Color fundus image; 2089x1764px — 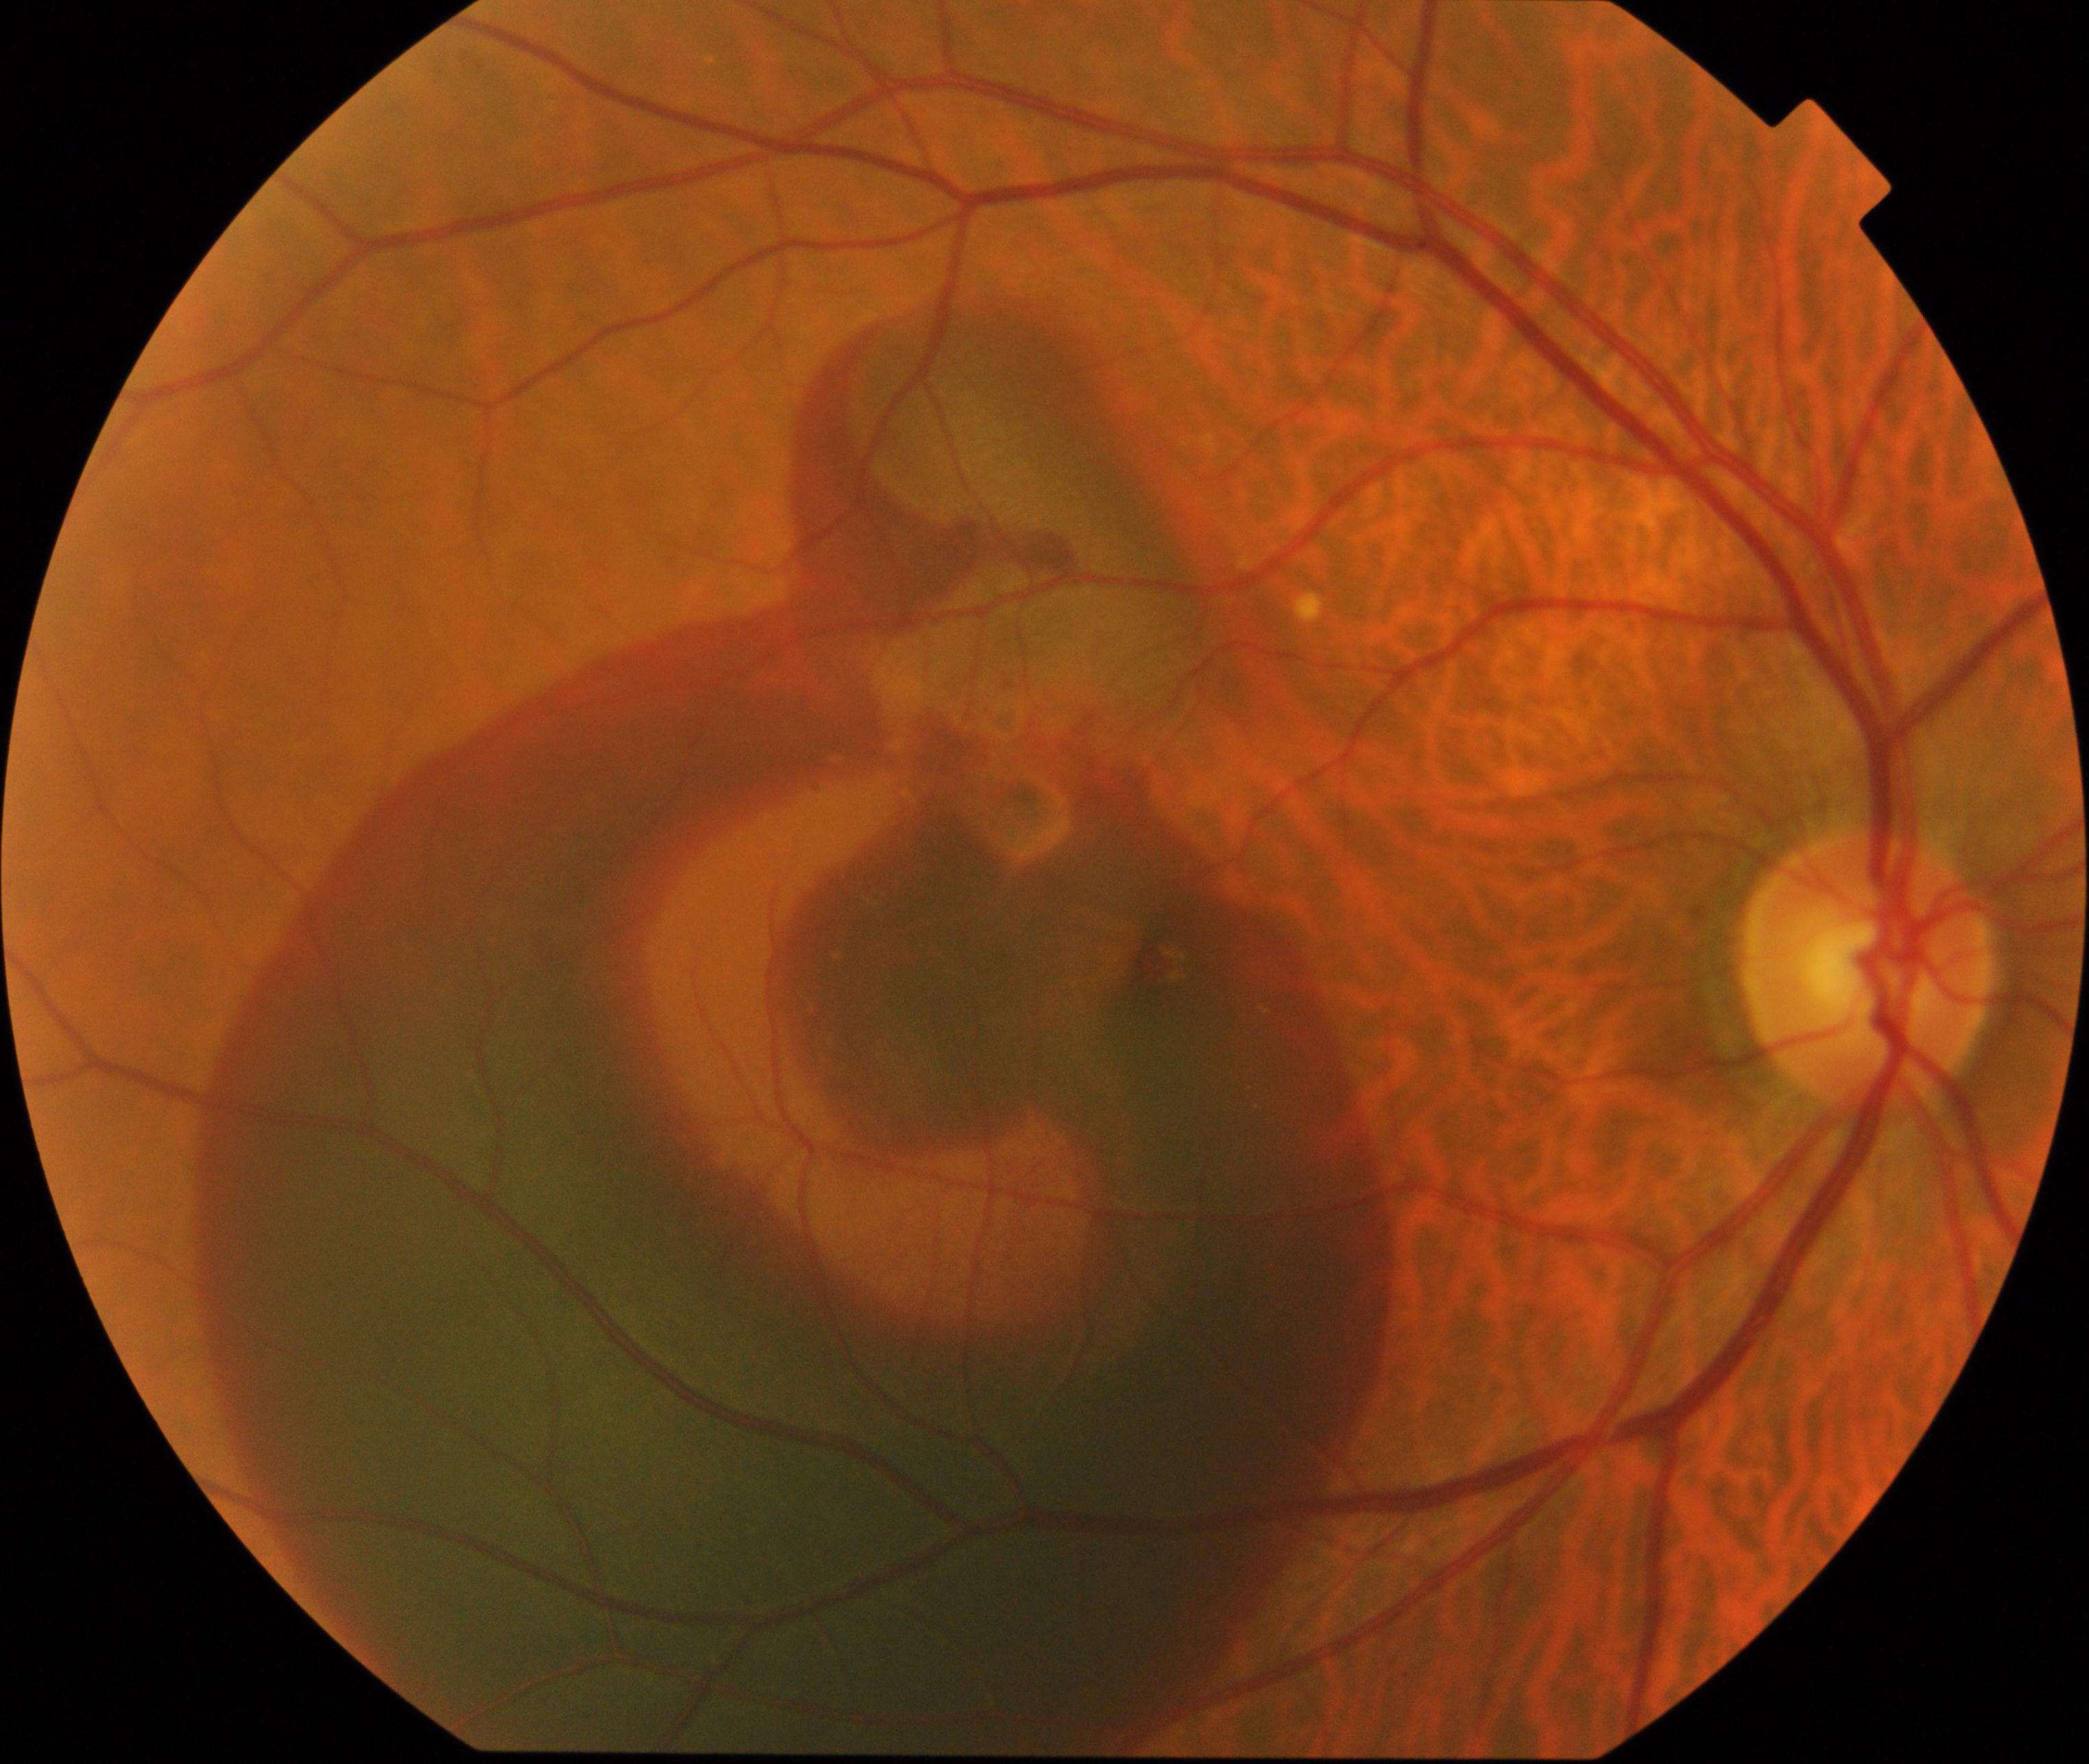

Diagnosis: maculopathy.